45-degree field of view.
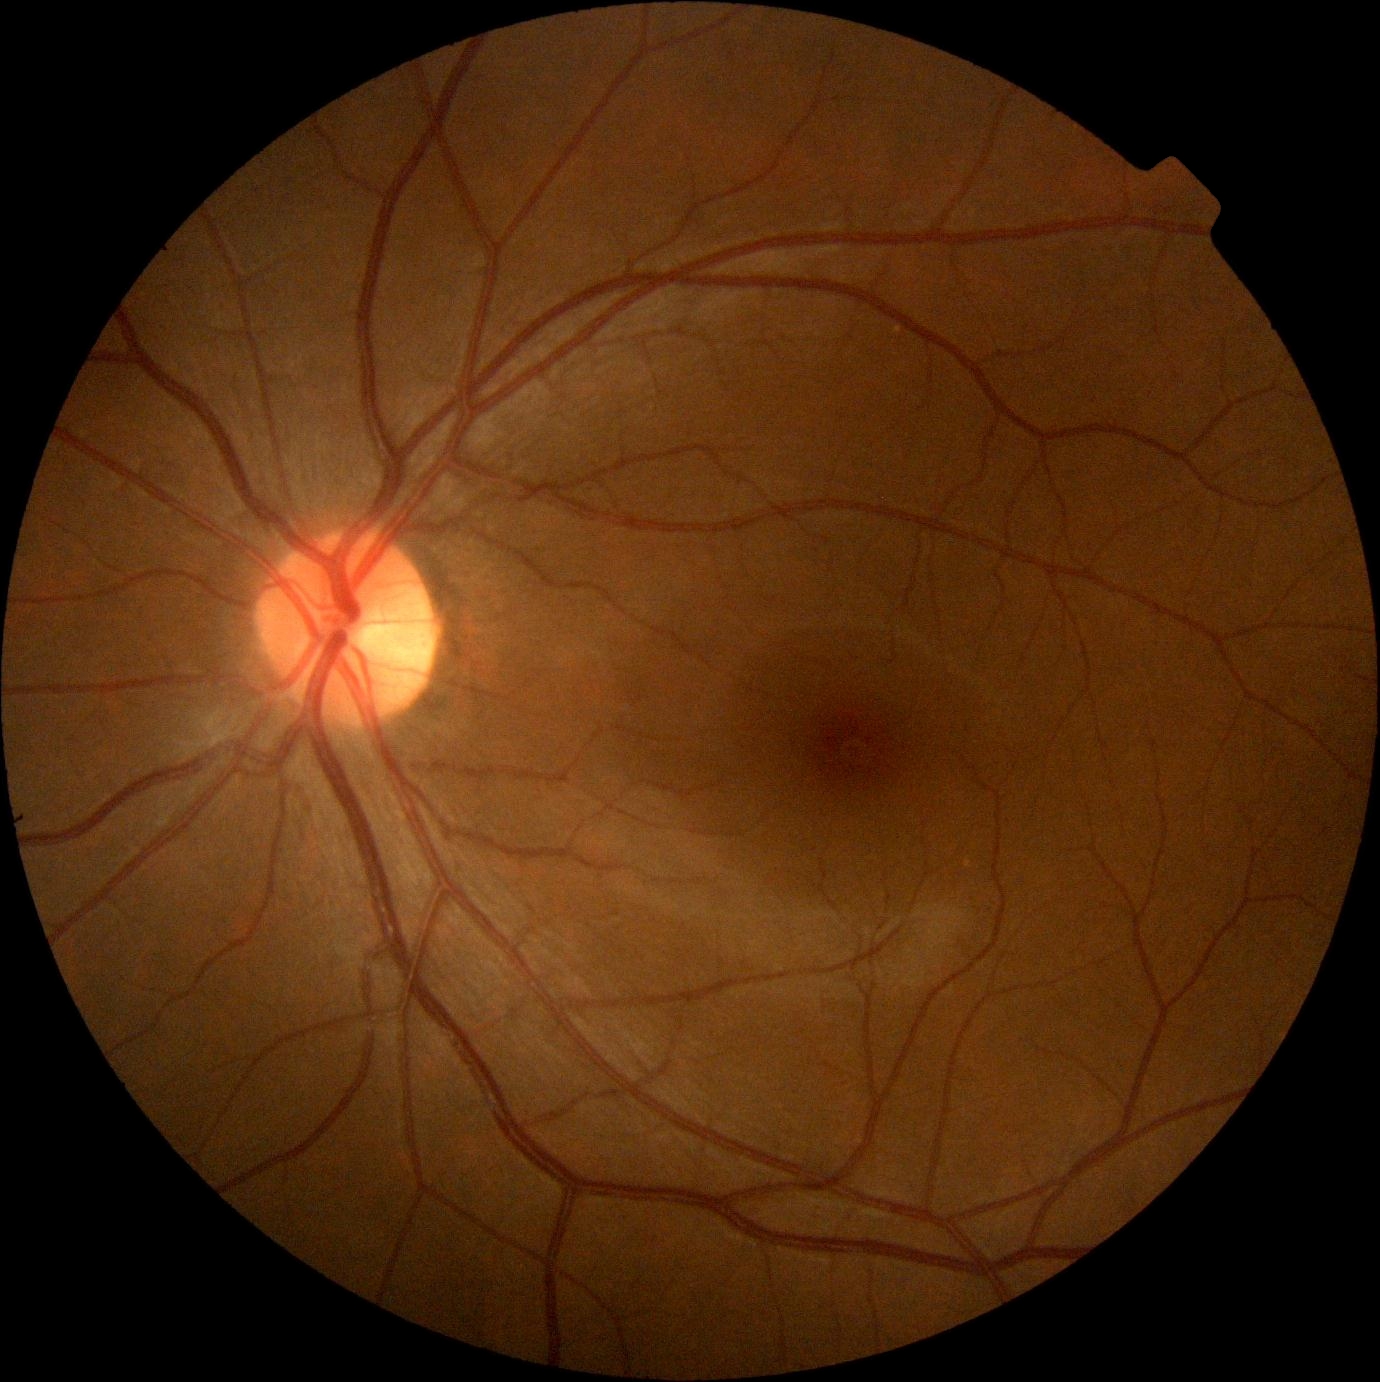

DR is 0/4 — no visible signs of diabetic retinopathy.
No diabetic retinal disease findings.